NIDEK AFC-230. Posterior pole color fundus photograph. FOV: 45 degrees. Nonmydriatic fundus photograph. 848x848px:
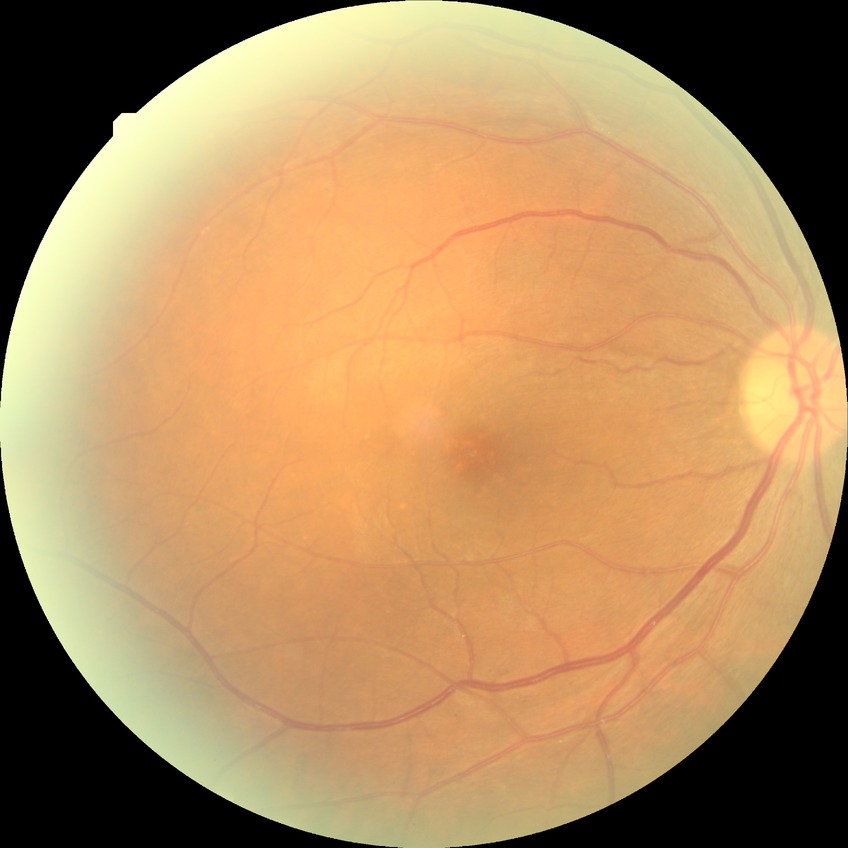

Diabetic retinopathy grade is simple diabetic retinopathy.